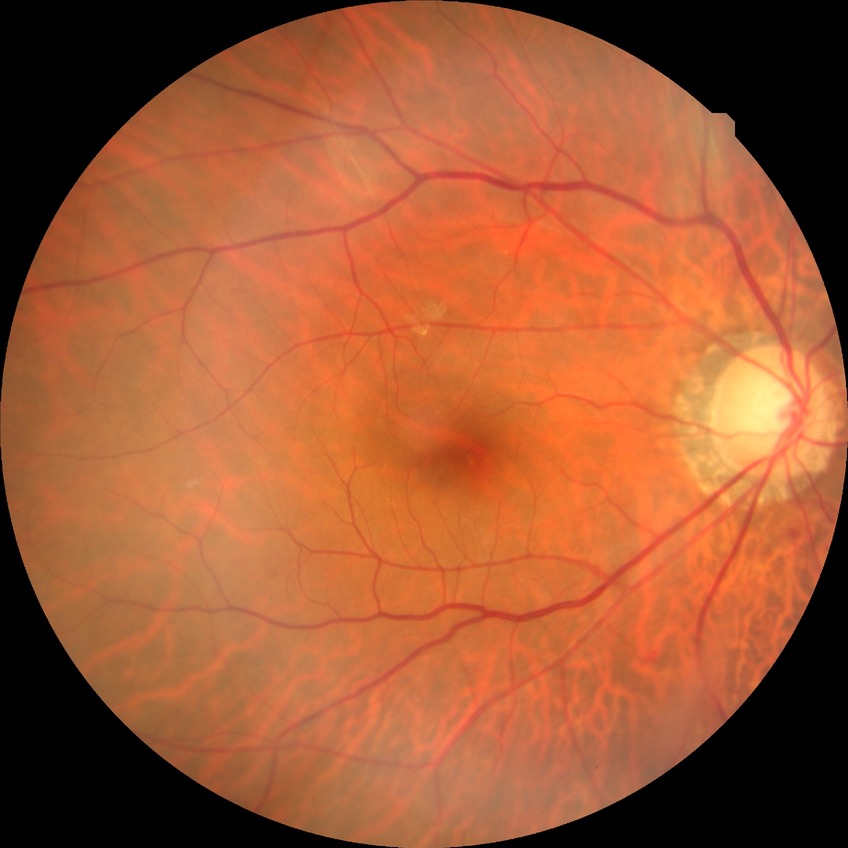

modified Davis grading=simple diabetic retinopathy.